DR severity per modified Davis staging:
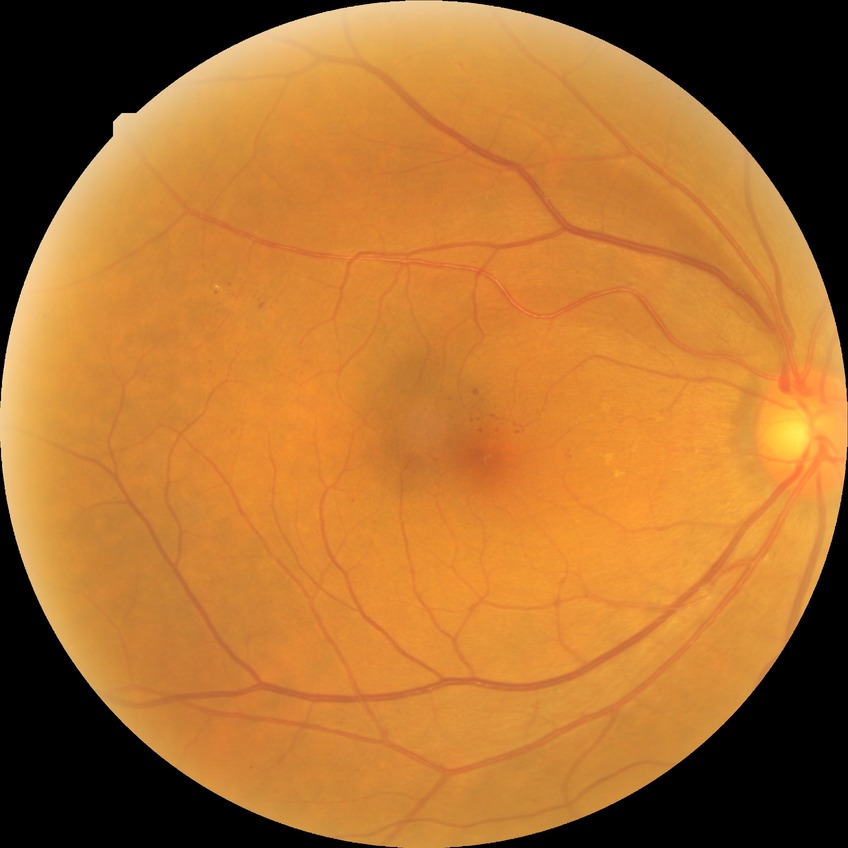

Assessment:
- diabetic retinopathy (DR): SDR (simple diabetic retinopathy)
- DR class: non-proliferative diabetic retinopathy